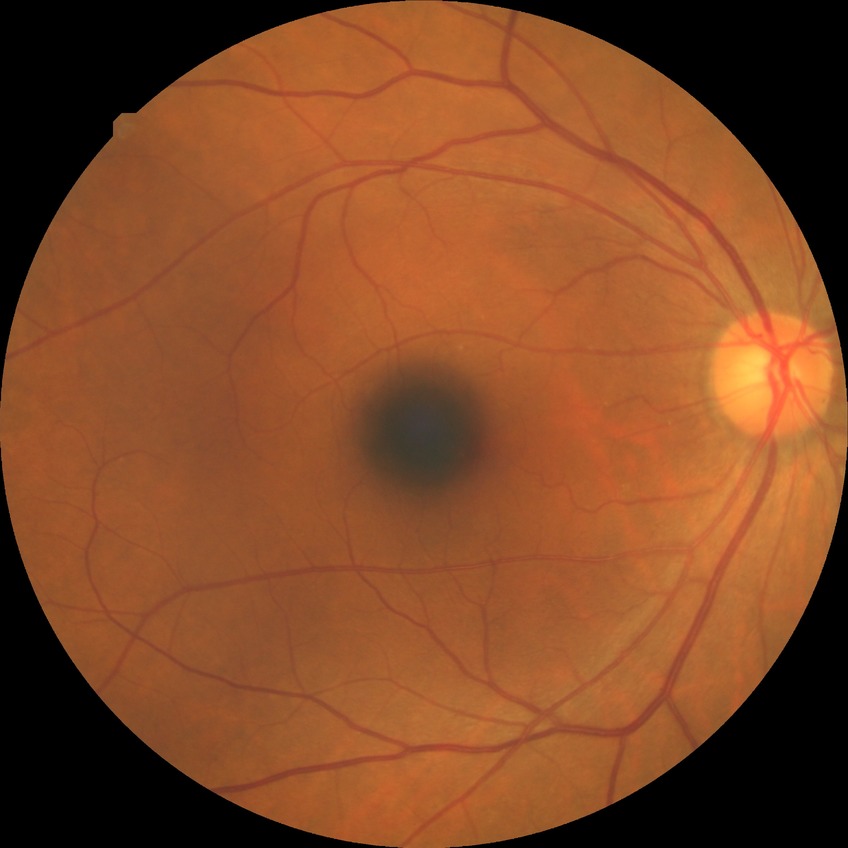
Assessment:
• diabetic retinopathy (DR): NDR (no diabetic retinopathy)